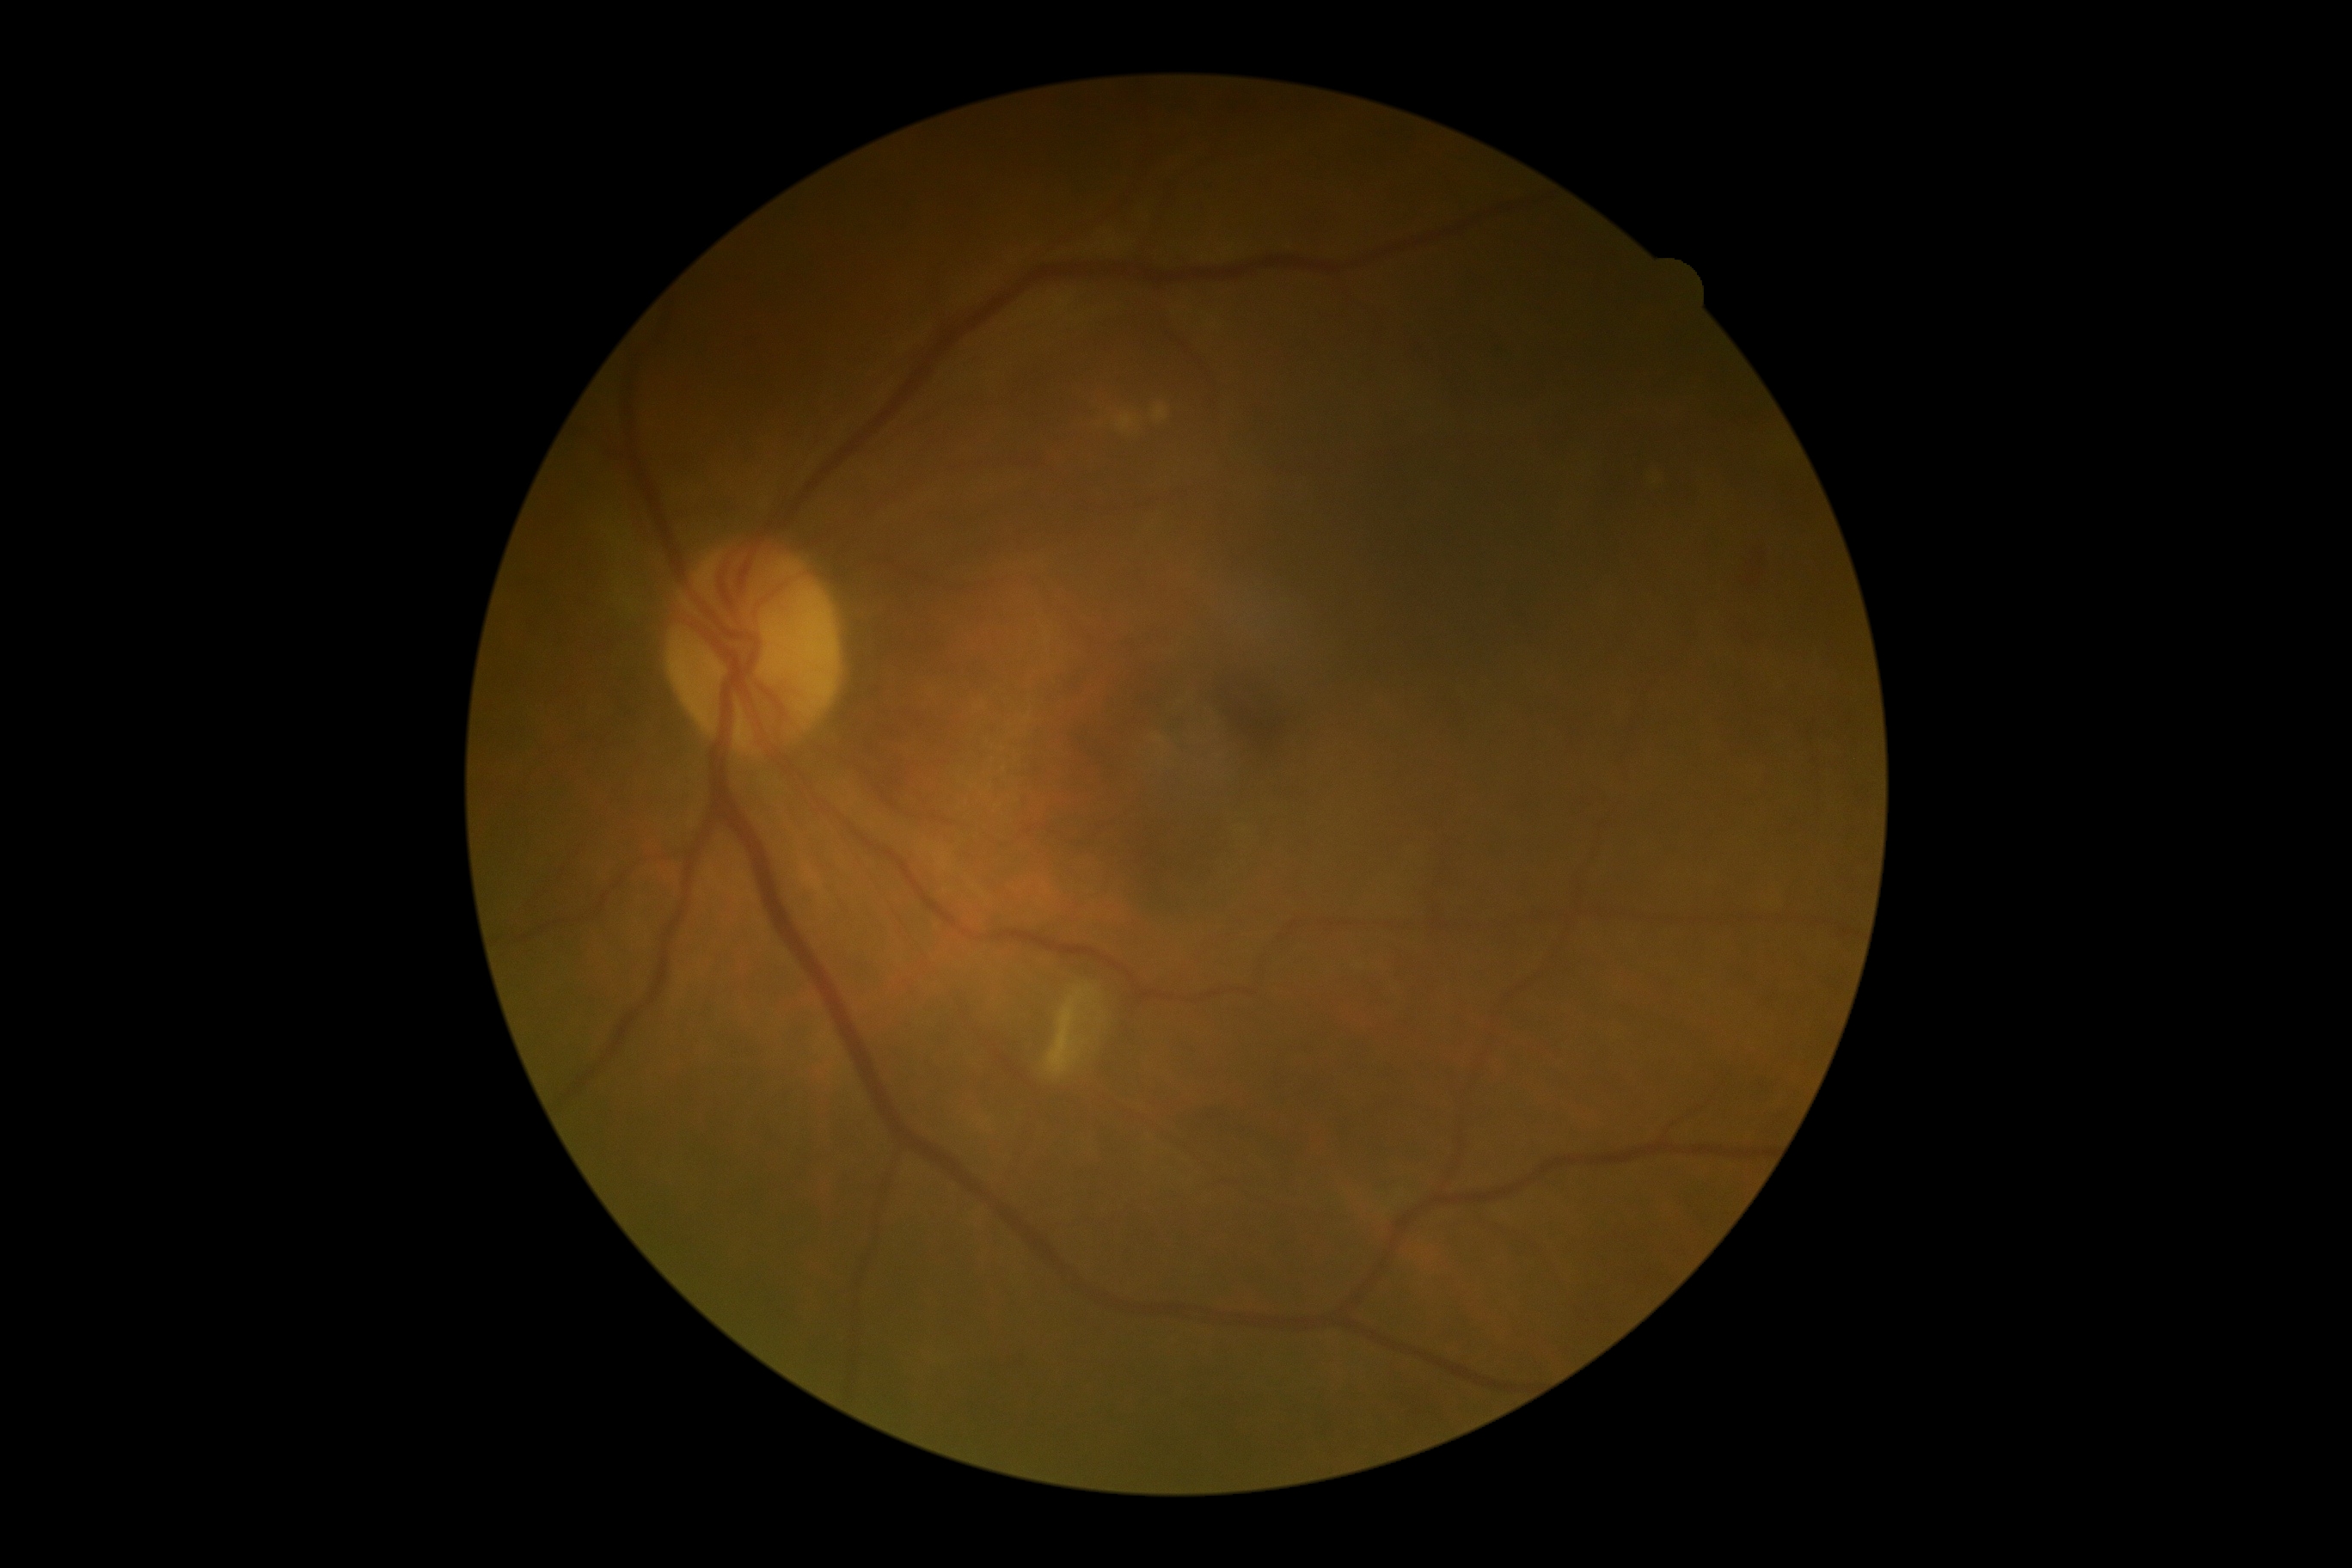
Retinopathy is 2.